45° FOV; CFP; 2352x1568px — 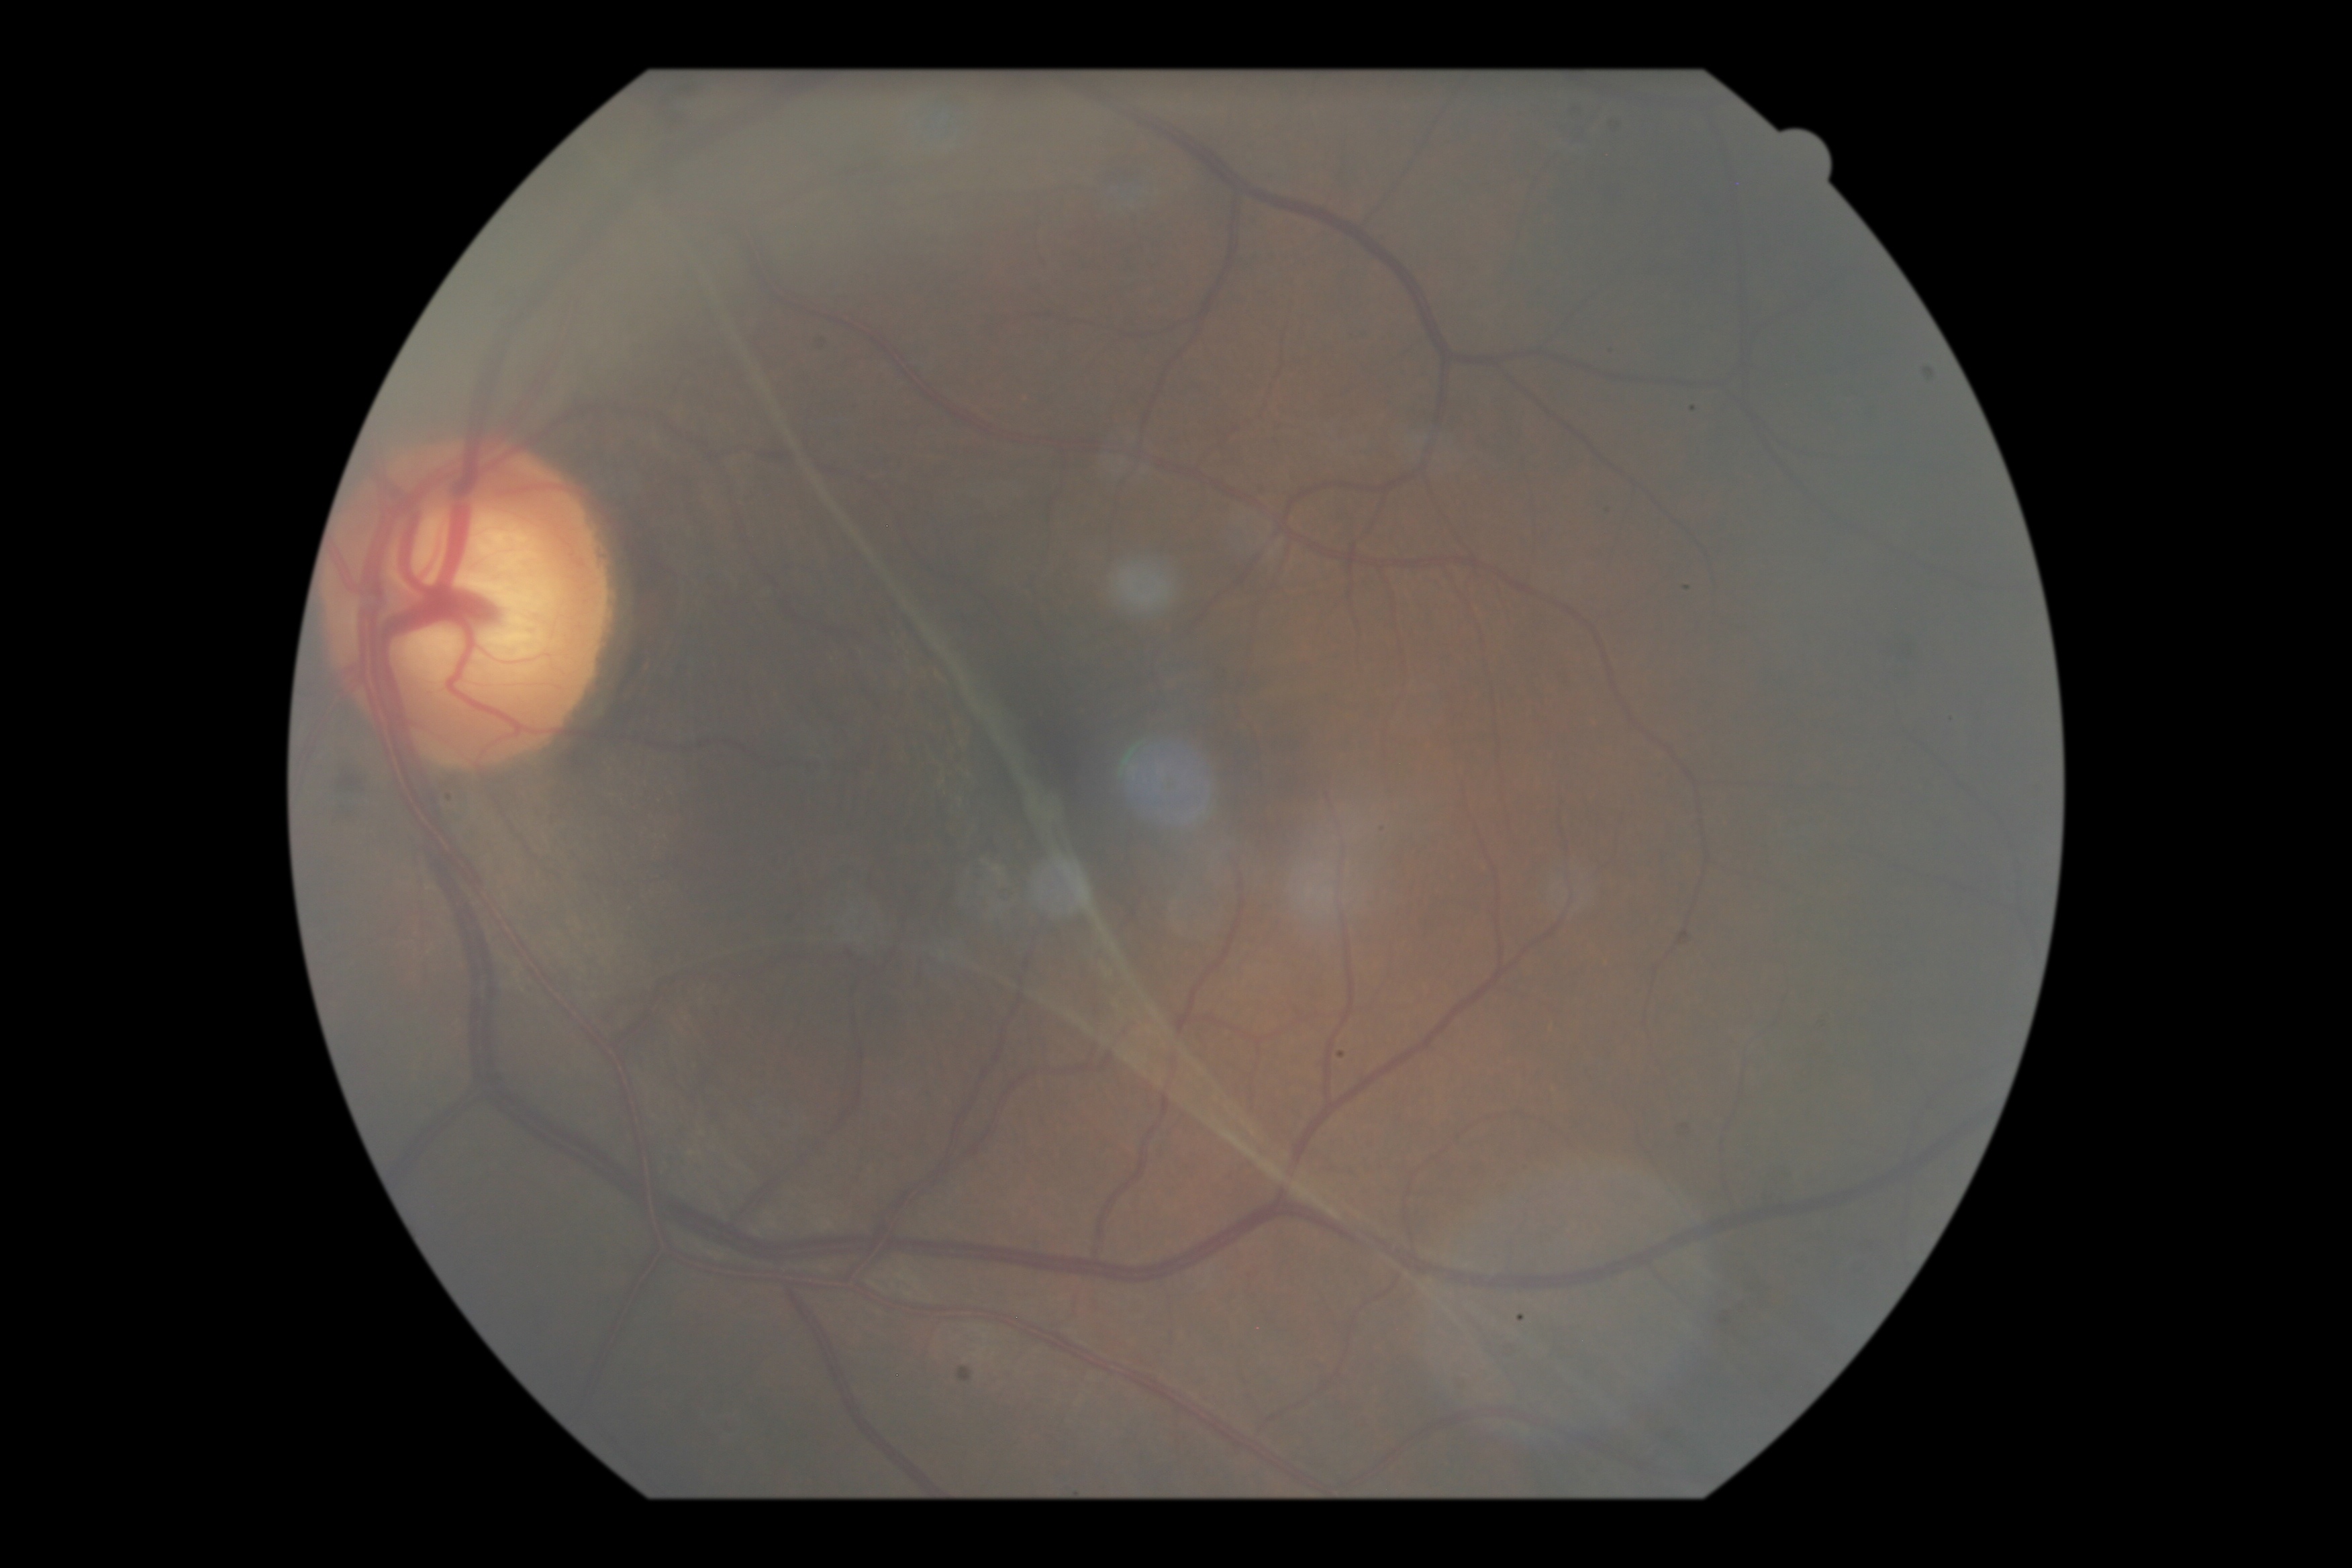 DR severity = PDR (grade 4); DR class = proliferative diabetic retinopathy.